Image size 1932x1932; Topcon TRC-NW8 — 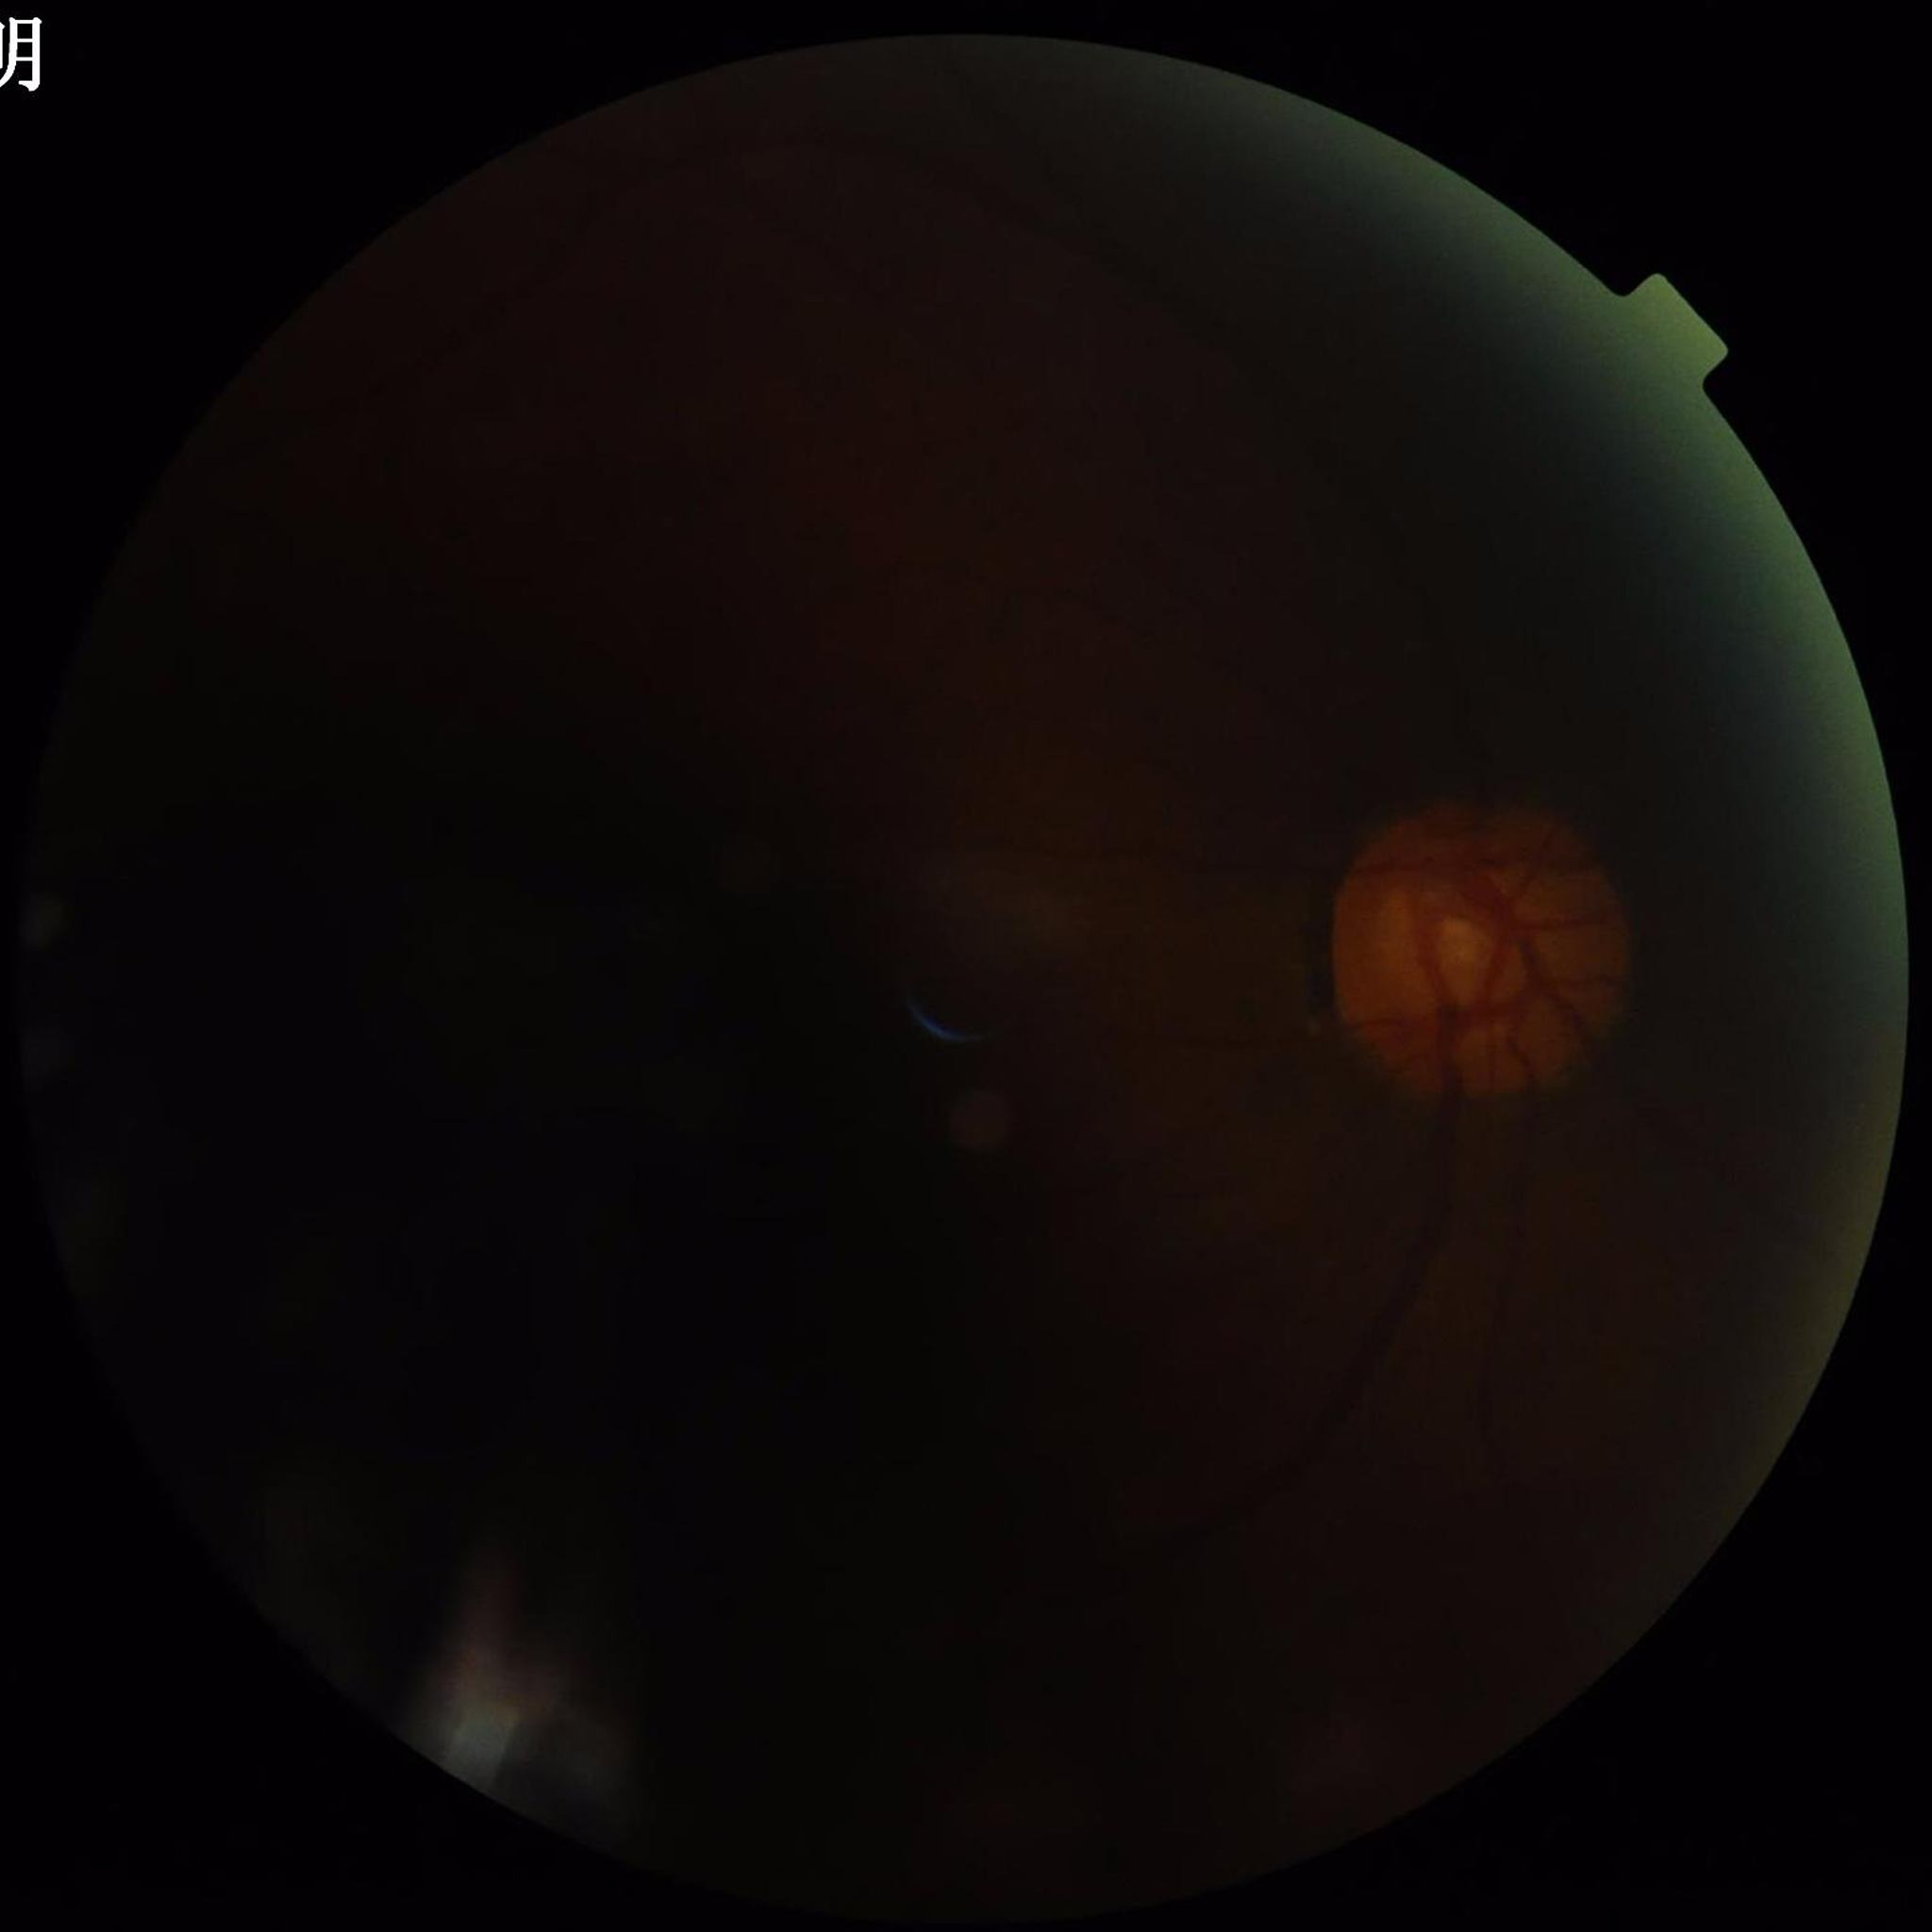 Retinal fundus photograph from a patient with glaucoma.
Quality assessment: low contrast, blur present, illumination/color distortion present.